848 by 848 pixels; no pharmacologic dilation
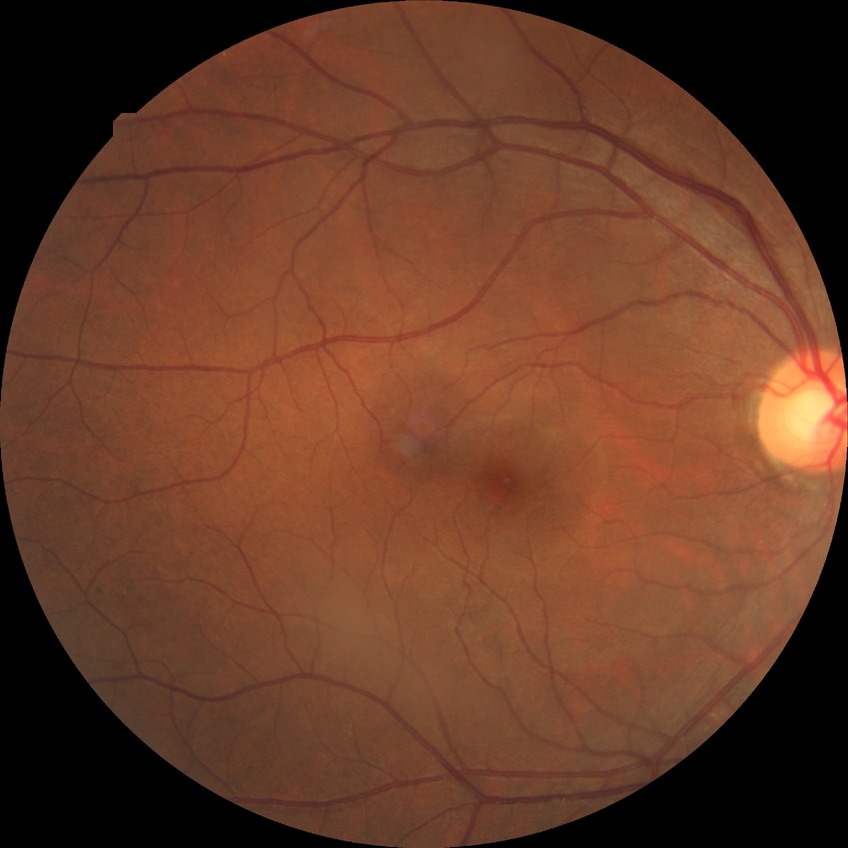

diabetic retinopathy grade = no diabetic retinopathy.